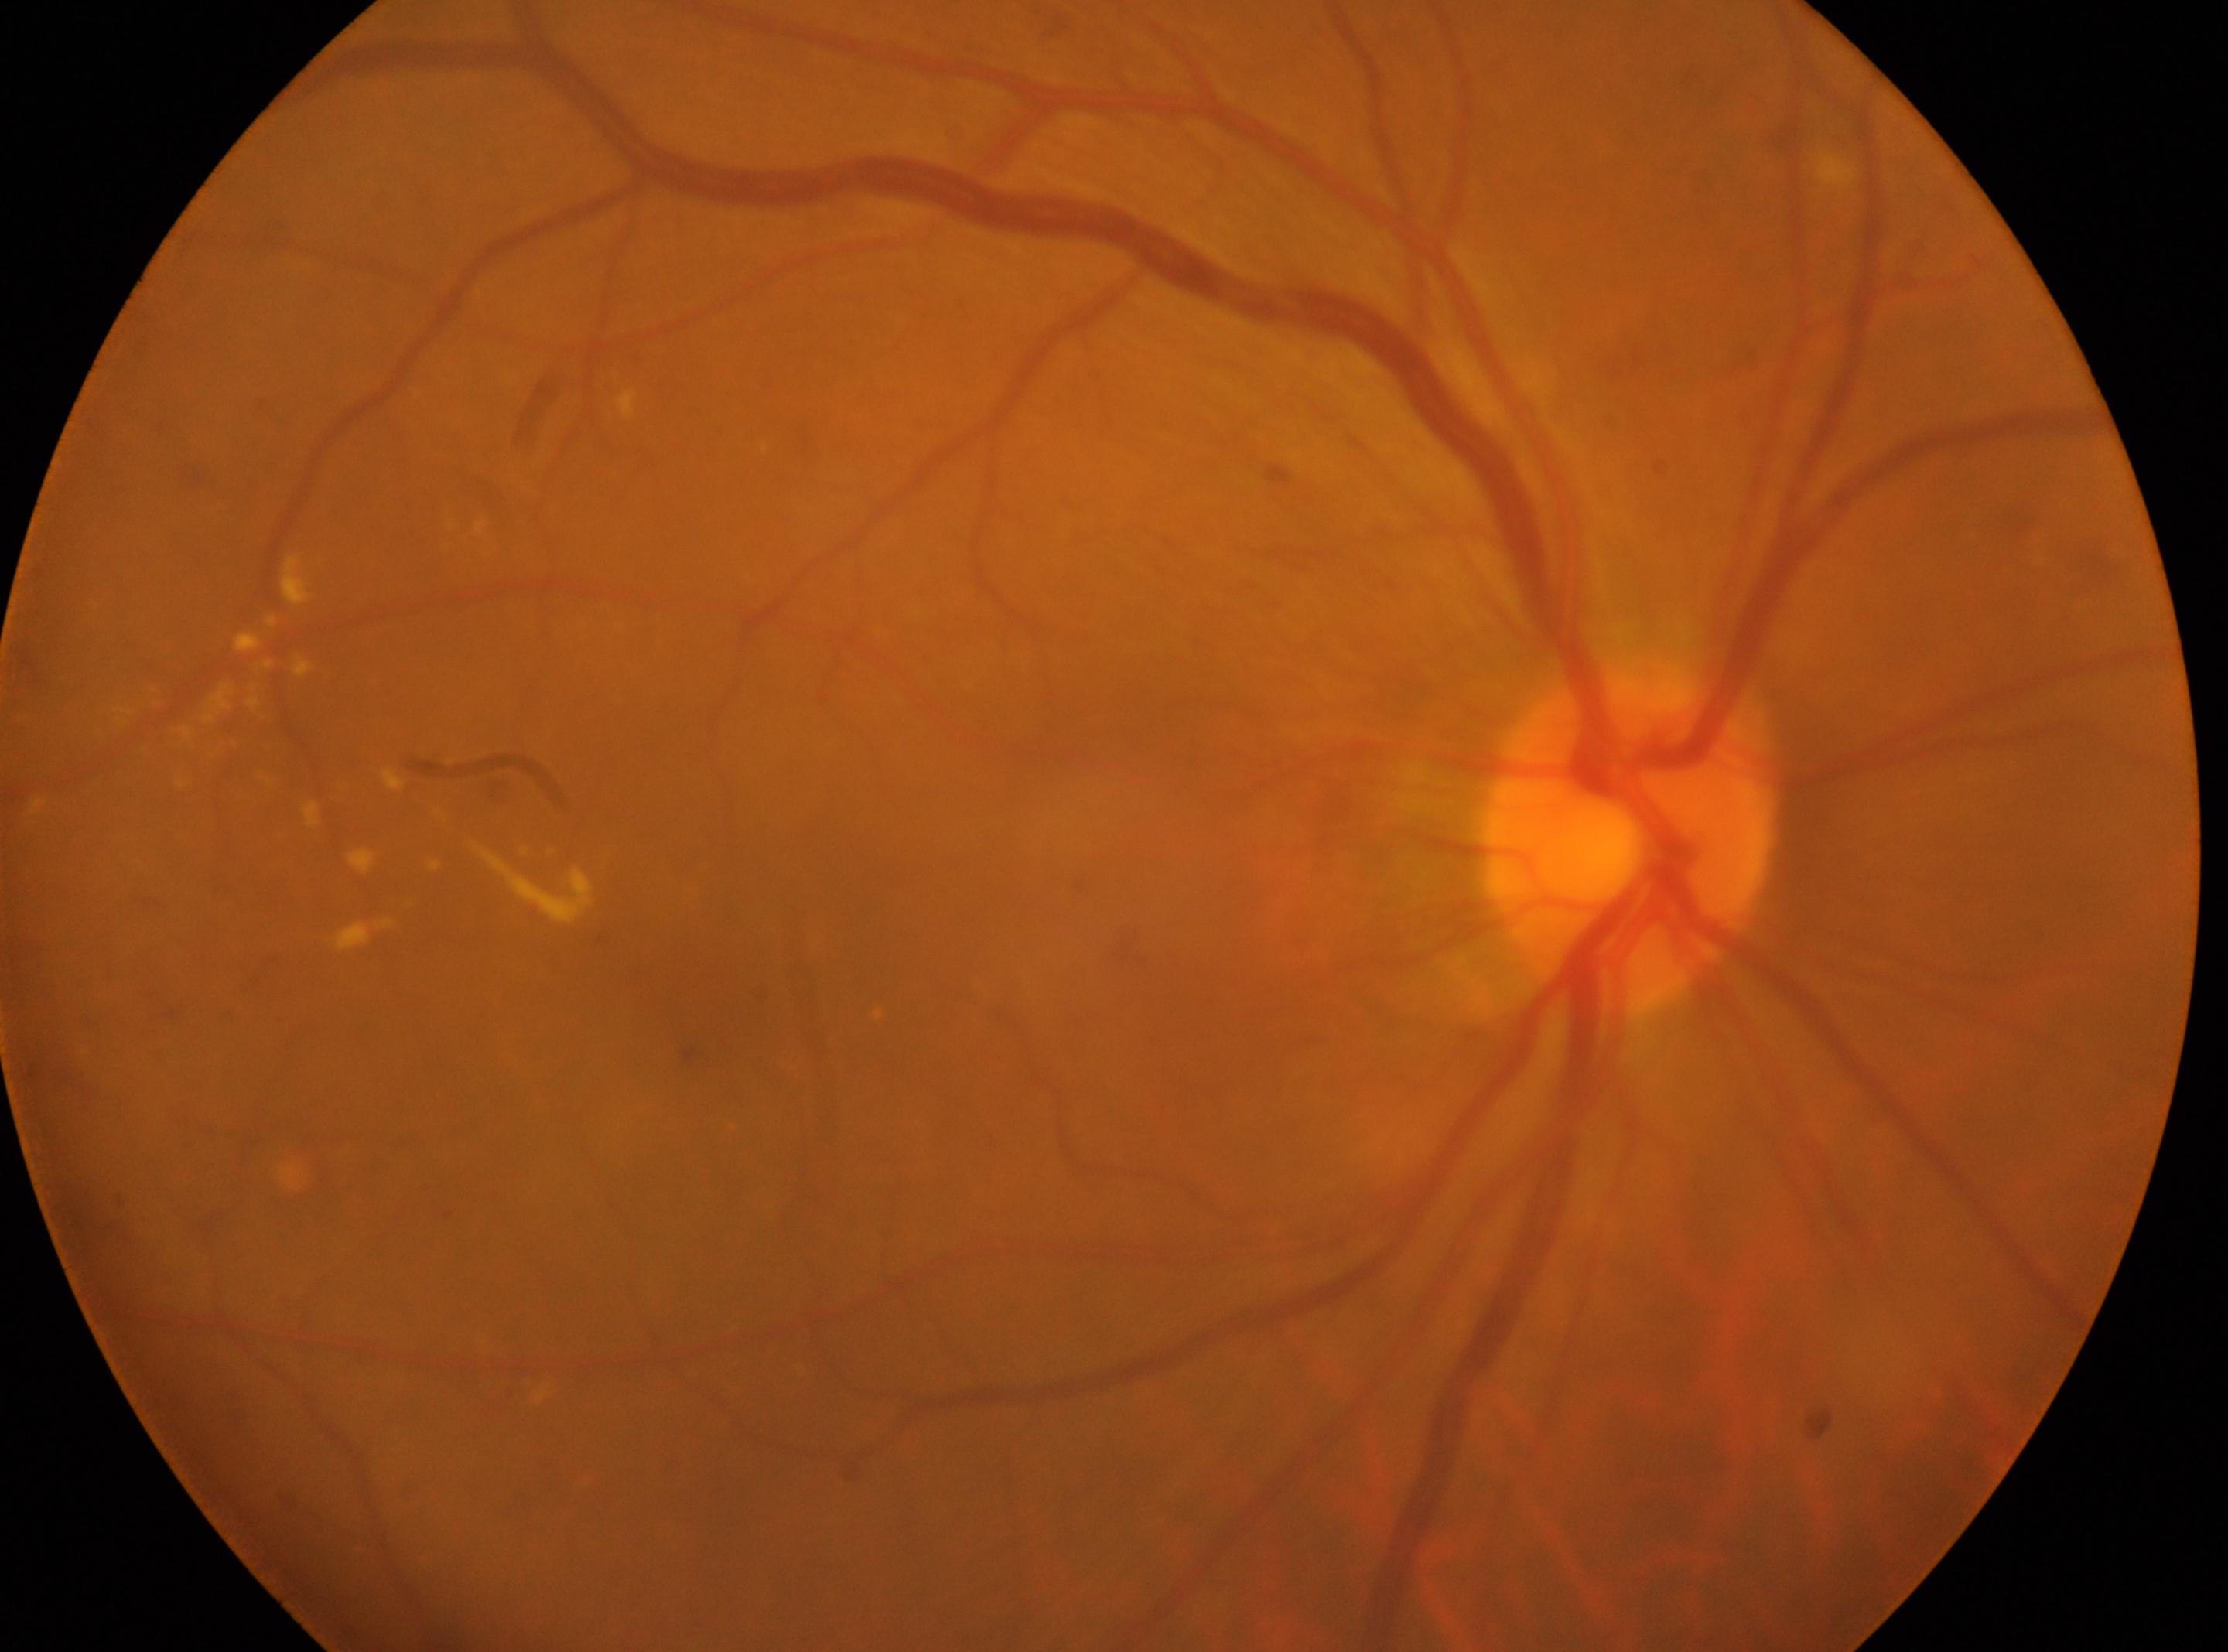
macular center: (709,970)
non-proliferative diabetic retinopathy
optic disk: (1628,842)
diabetic retinopathy (DR): 2
the right eye